45° FOV; color fundus photograph: 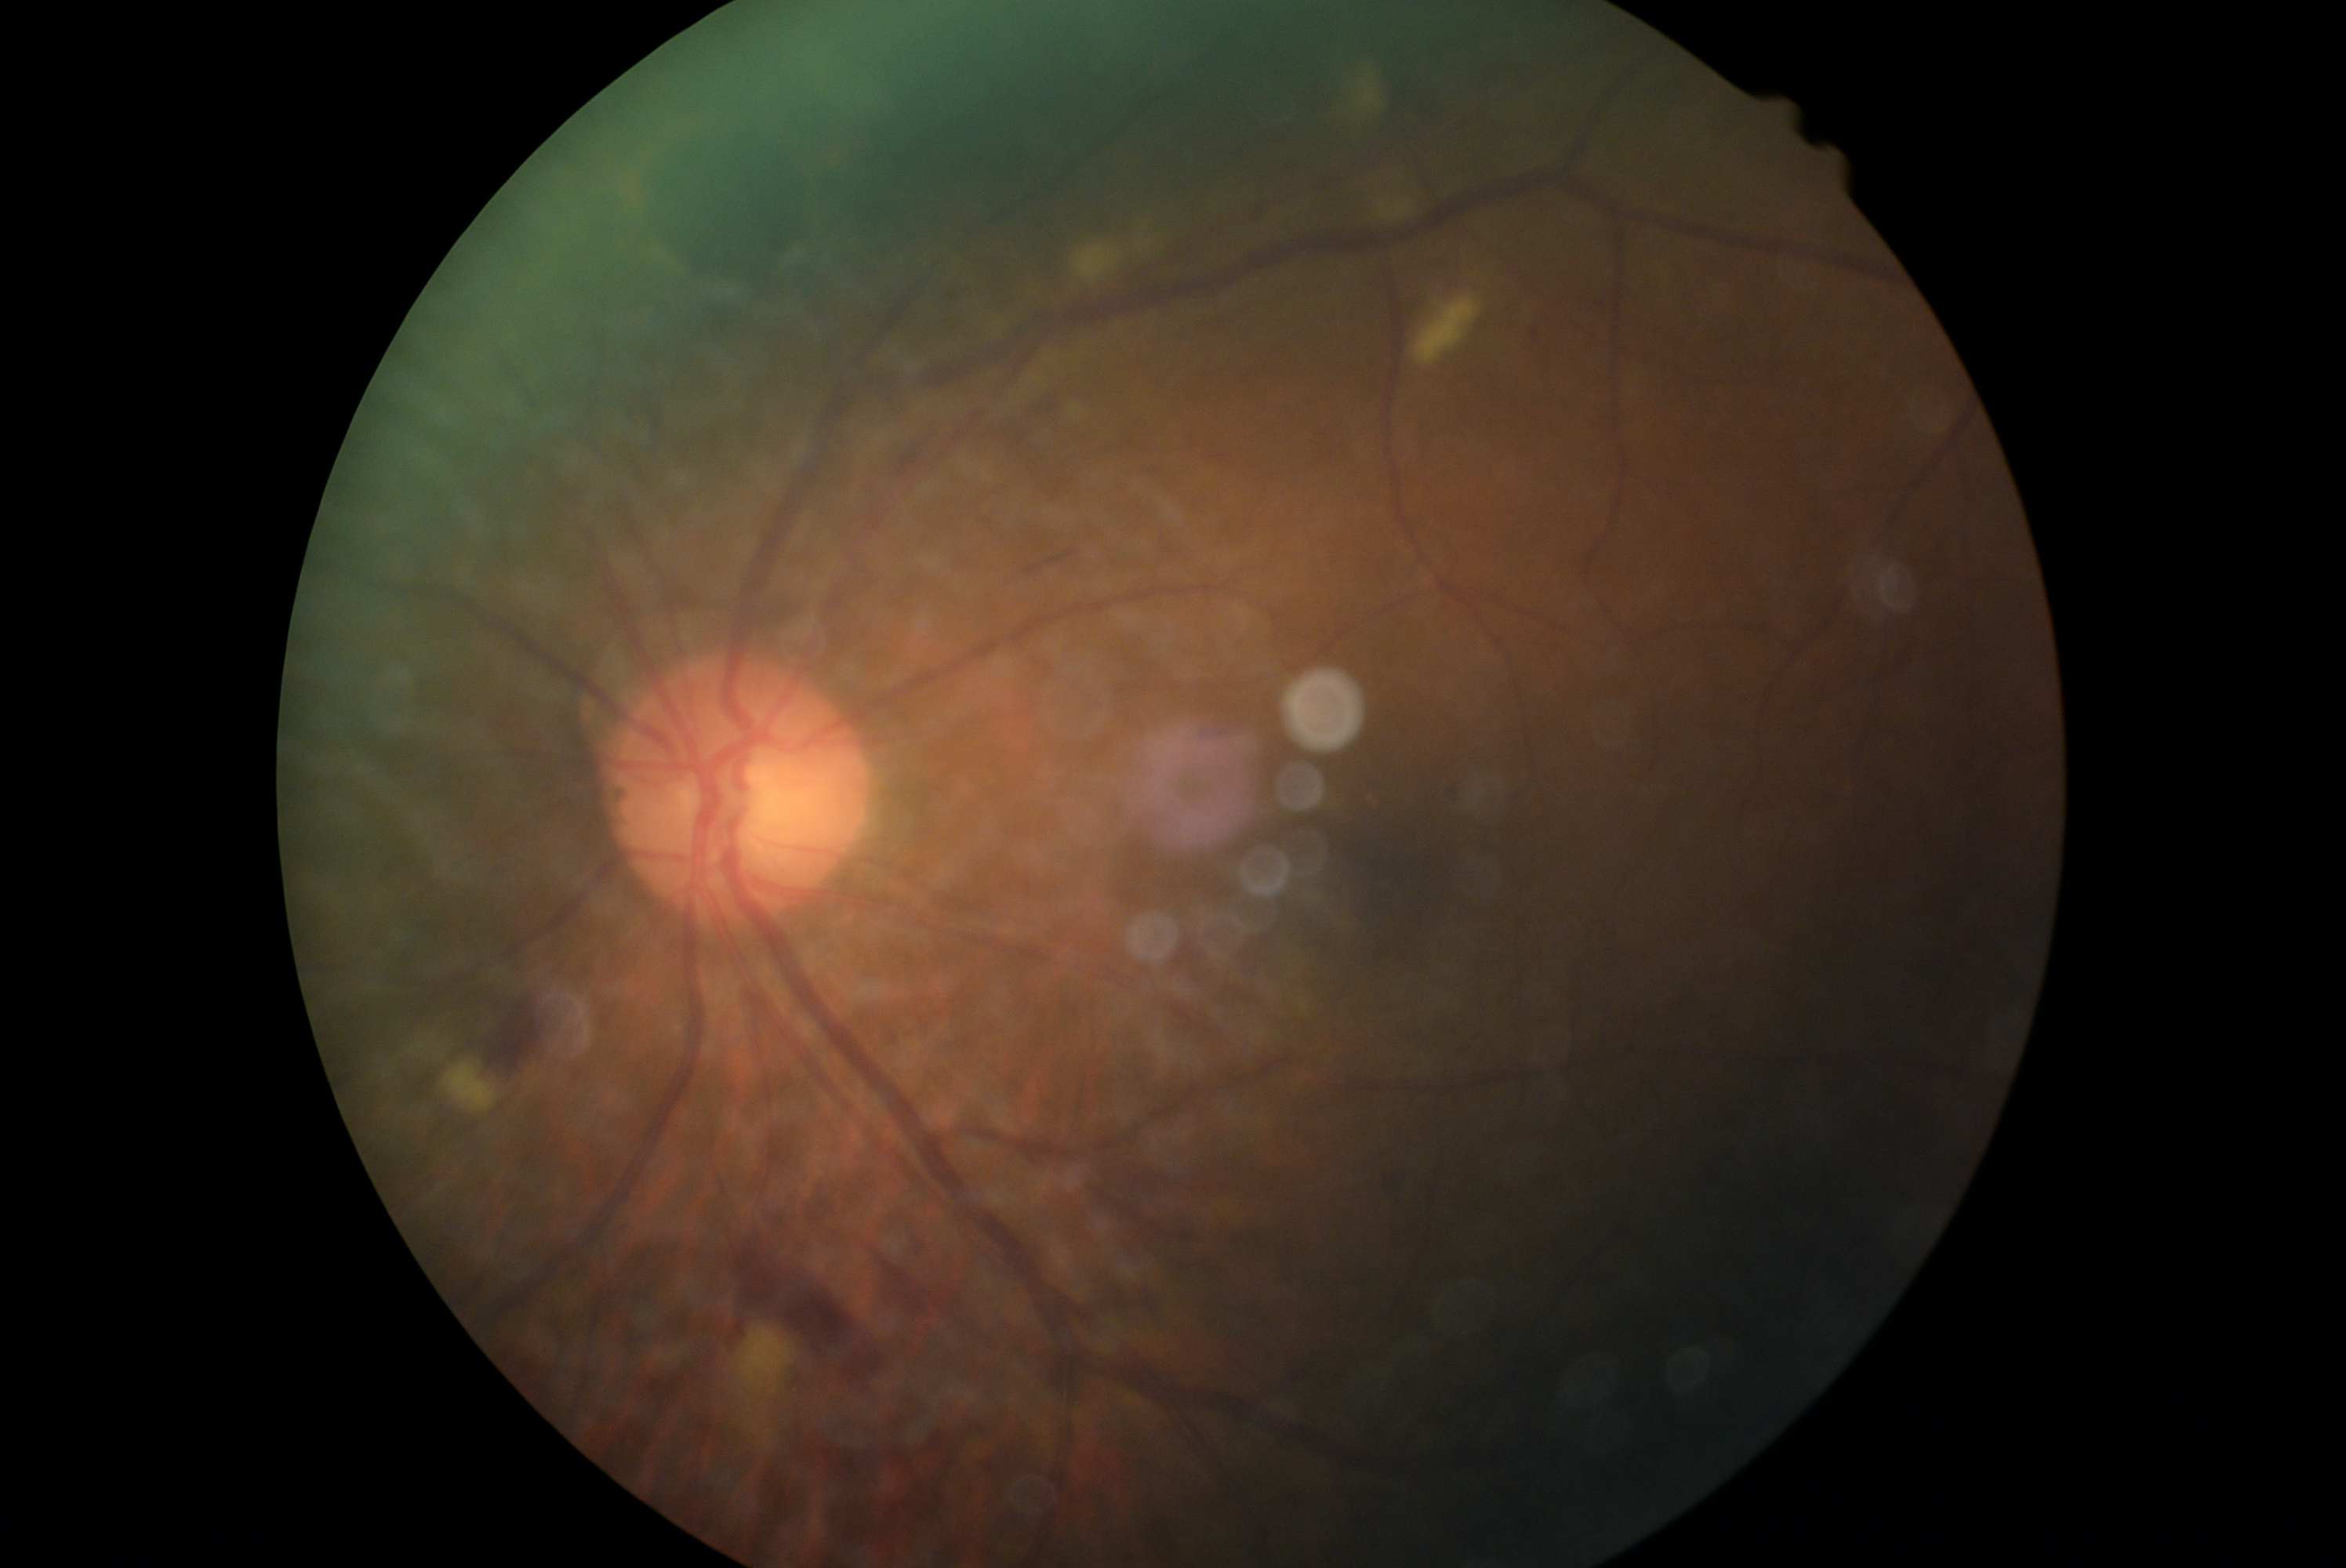

Diabetic retinopathy (DR) is moderate NPDR (grade 2).